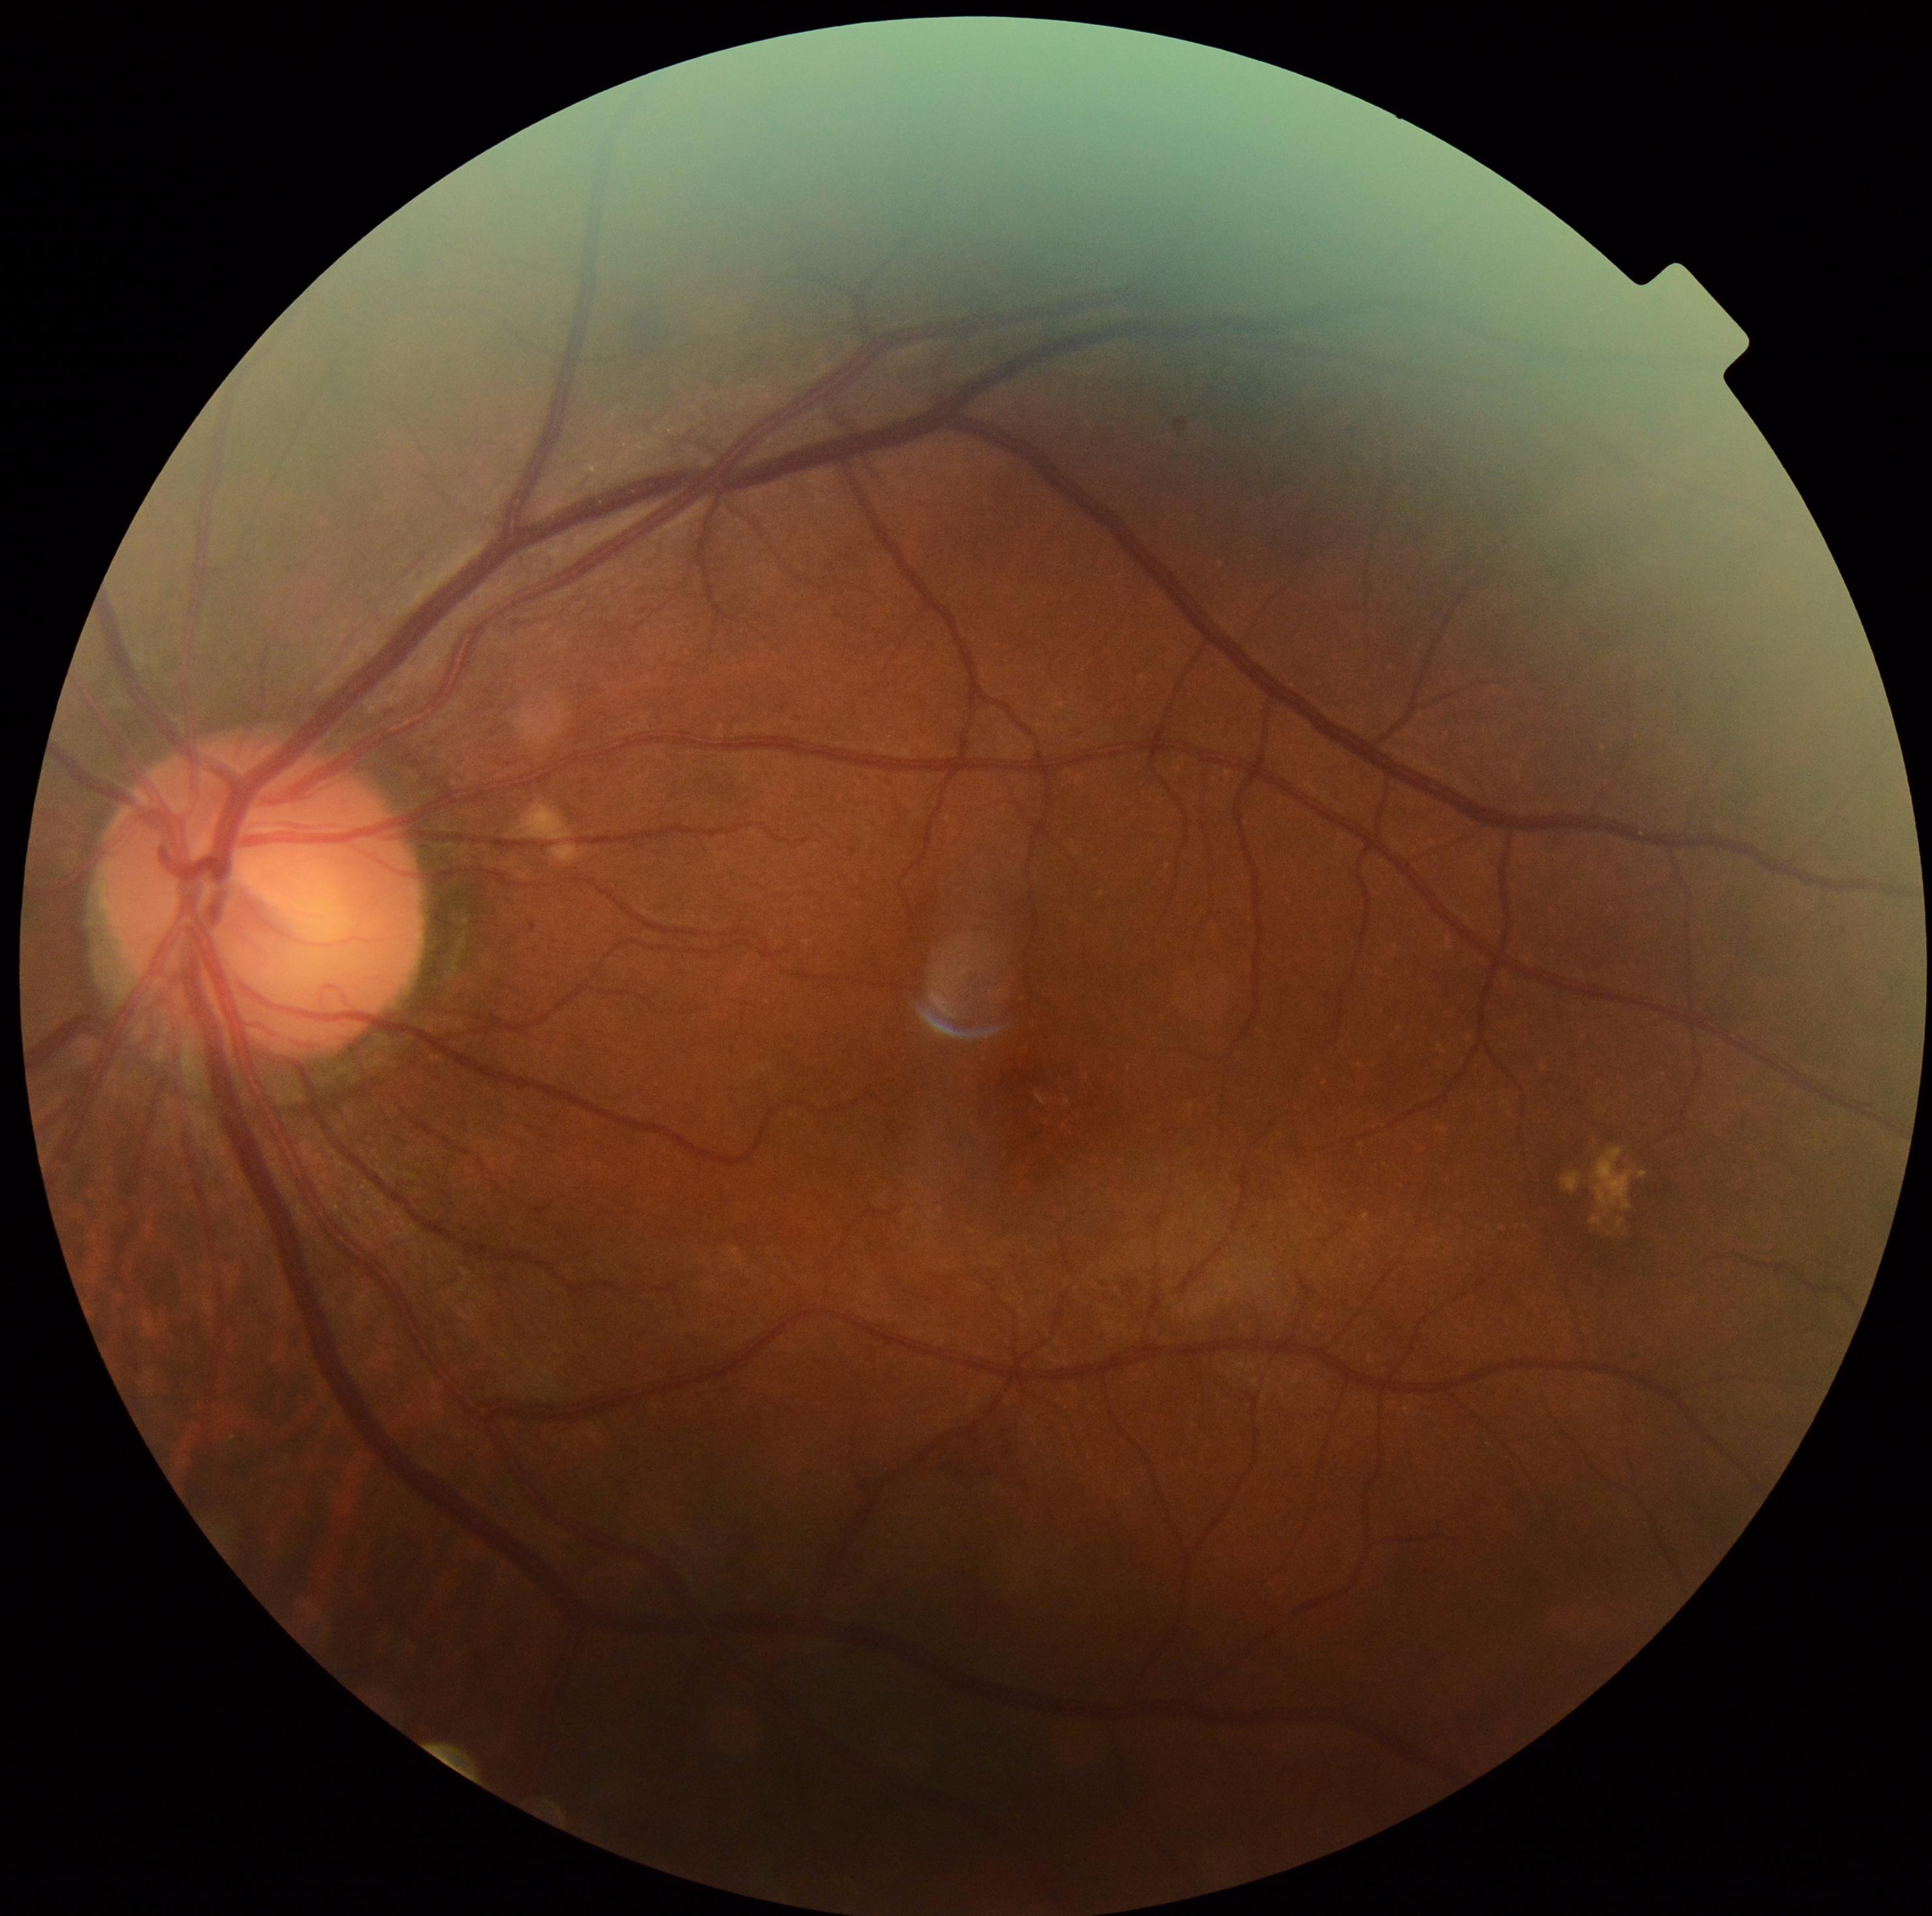

Retinopathy grade: 2/4.